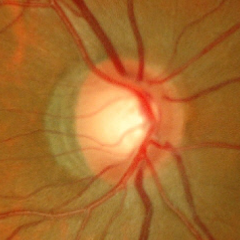

Glaucoma is present.
Early glaucomatous changes.
Diagnostic criteria: glaucomatous retinal nerve fiber layer defects on red-free fundus photography without visual field defects.